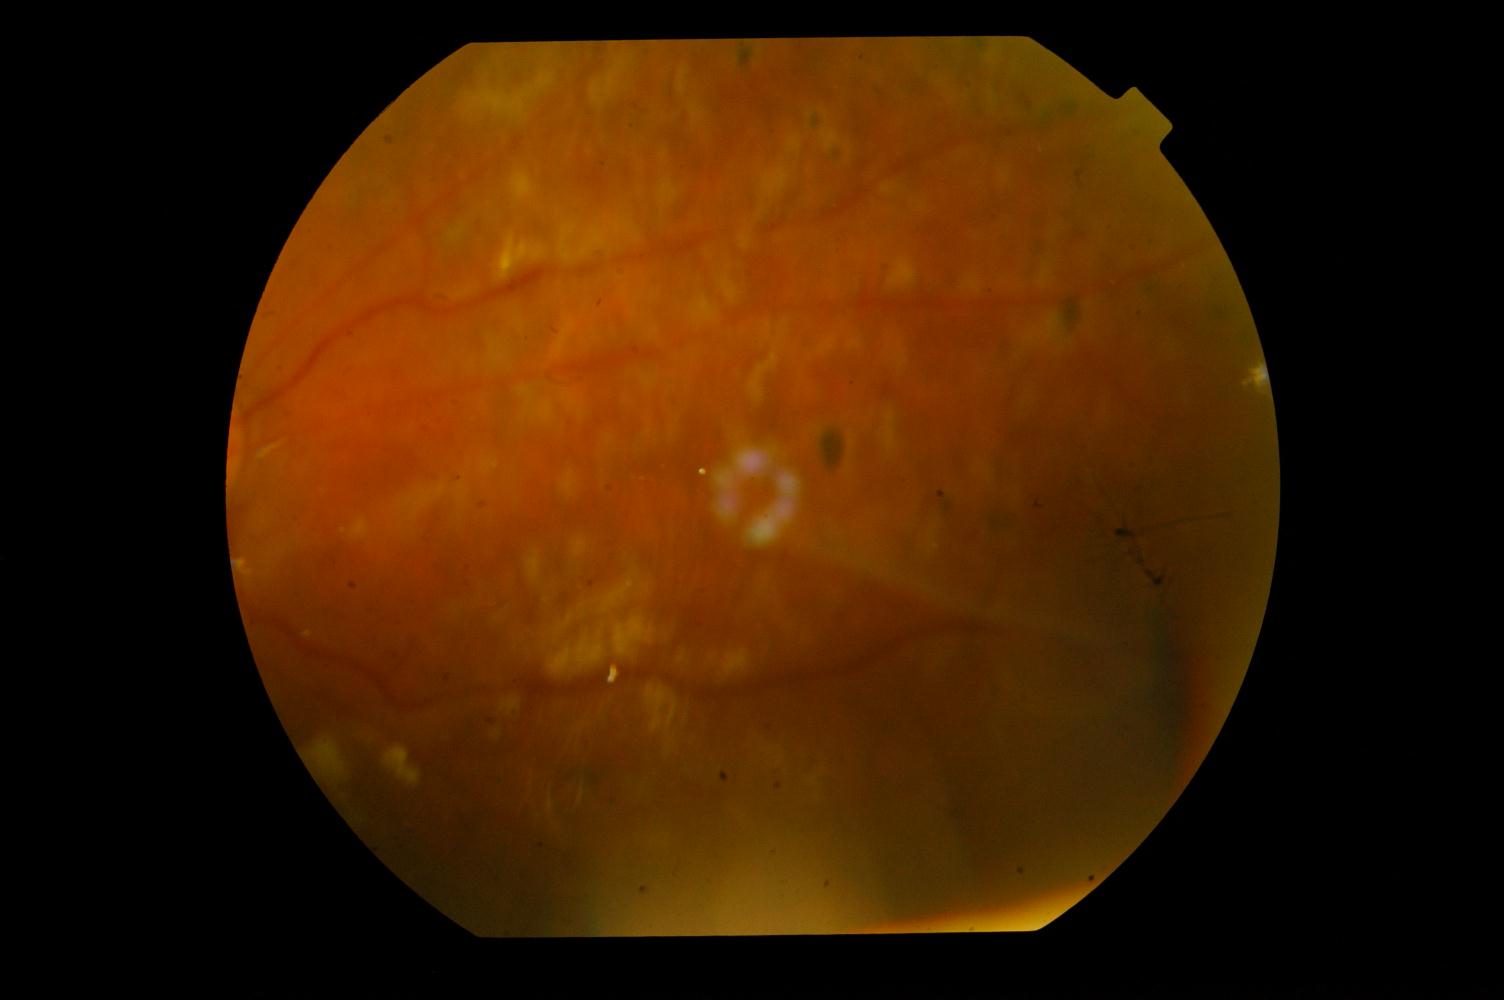

Diagnoses:
- diabetic retinopathy (DR)